Pachymetry 556 µm — 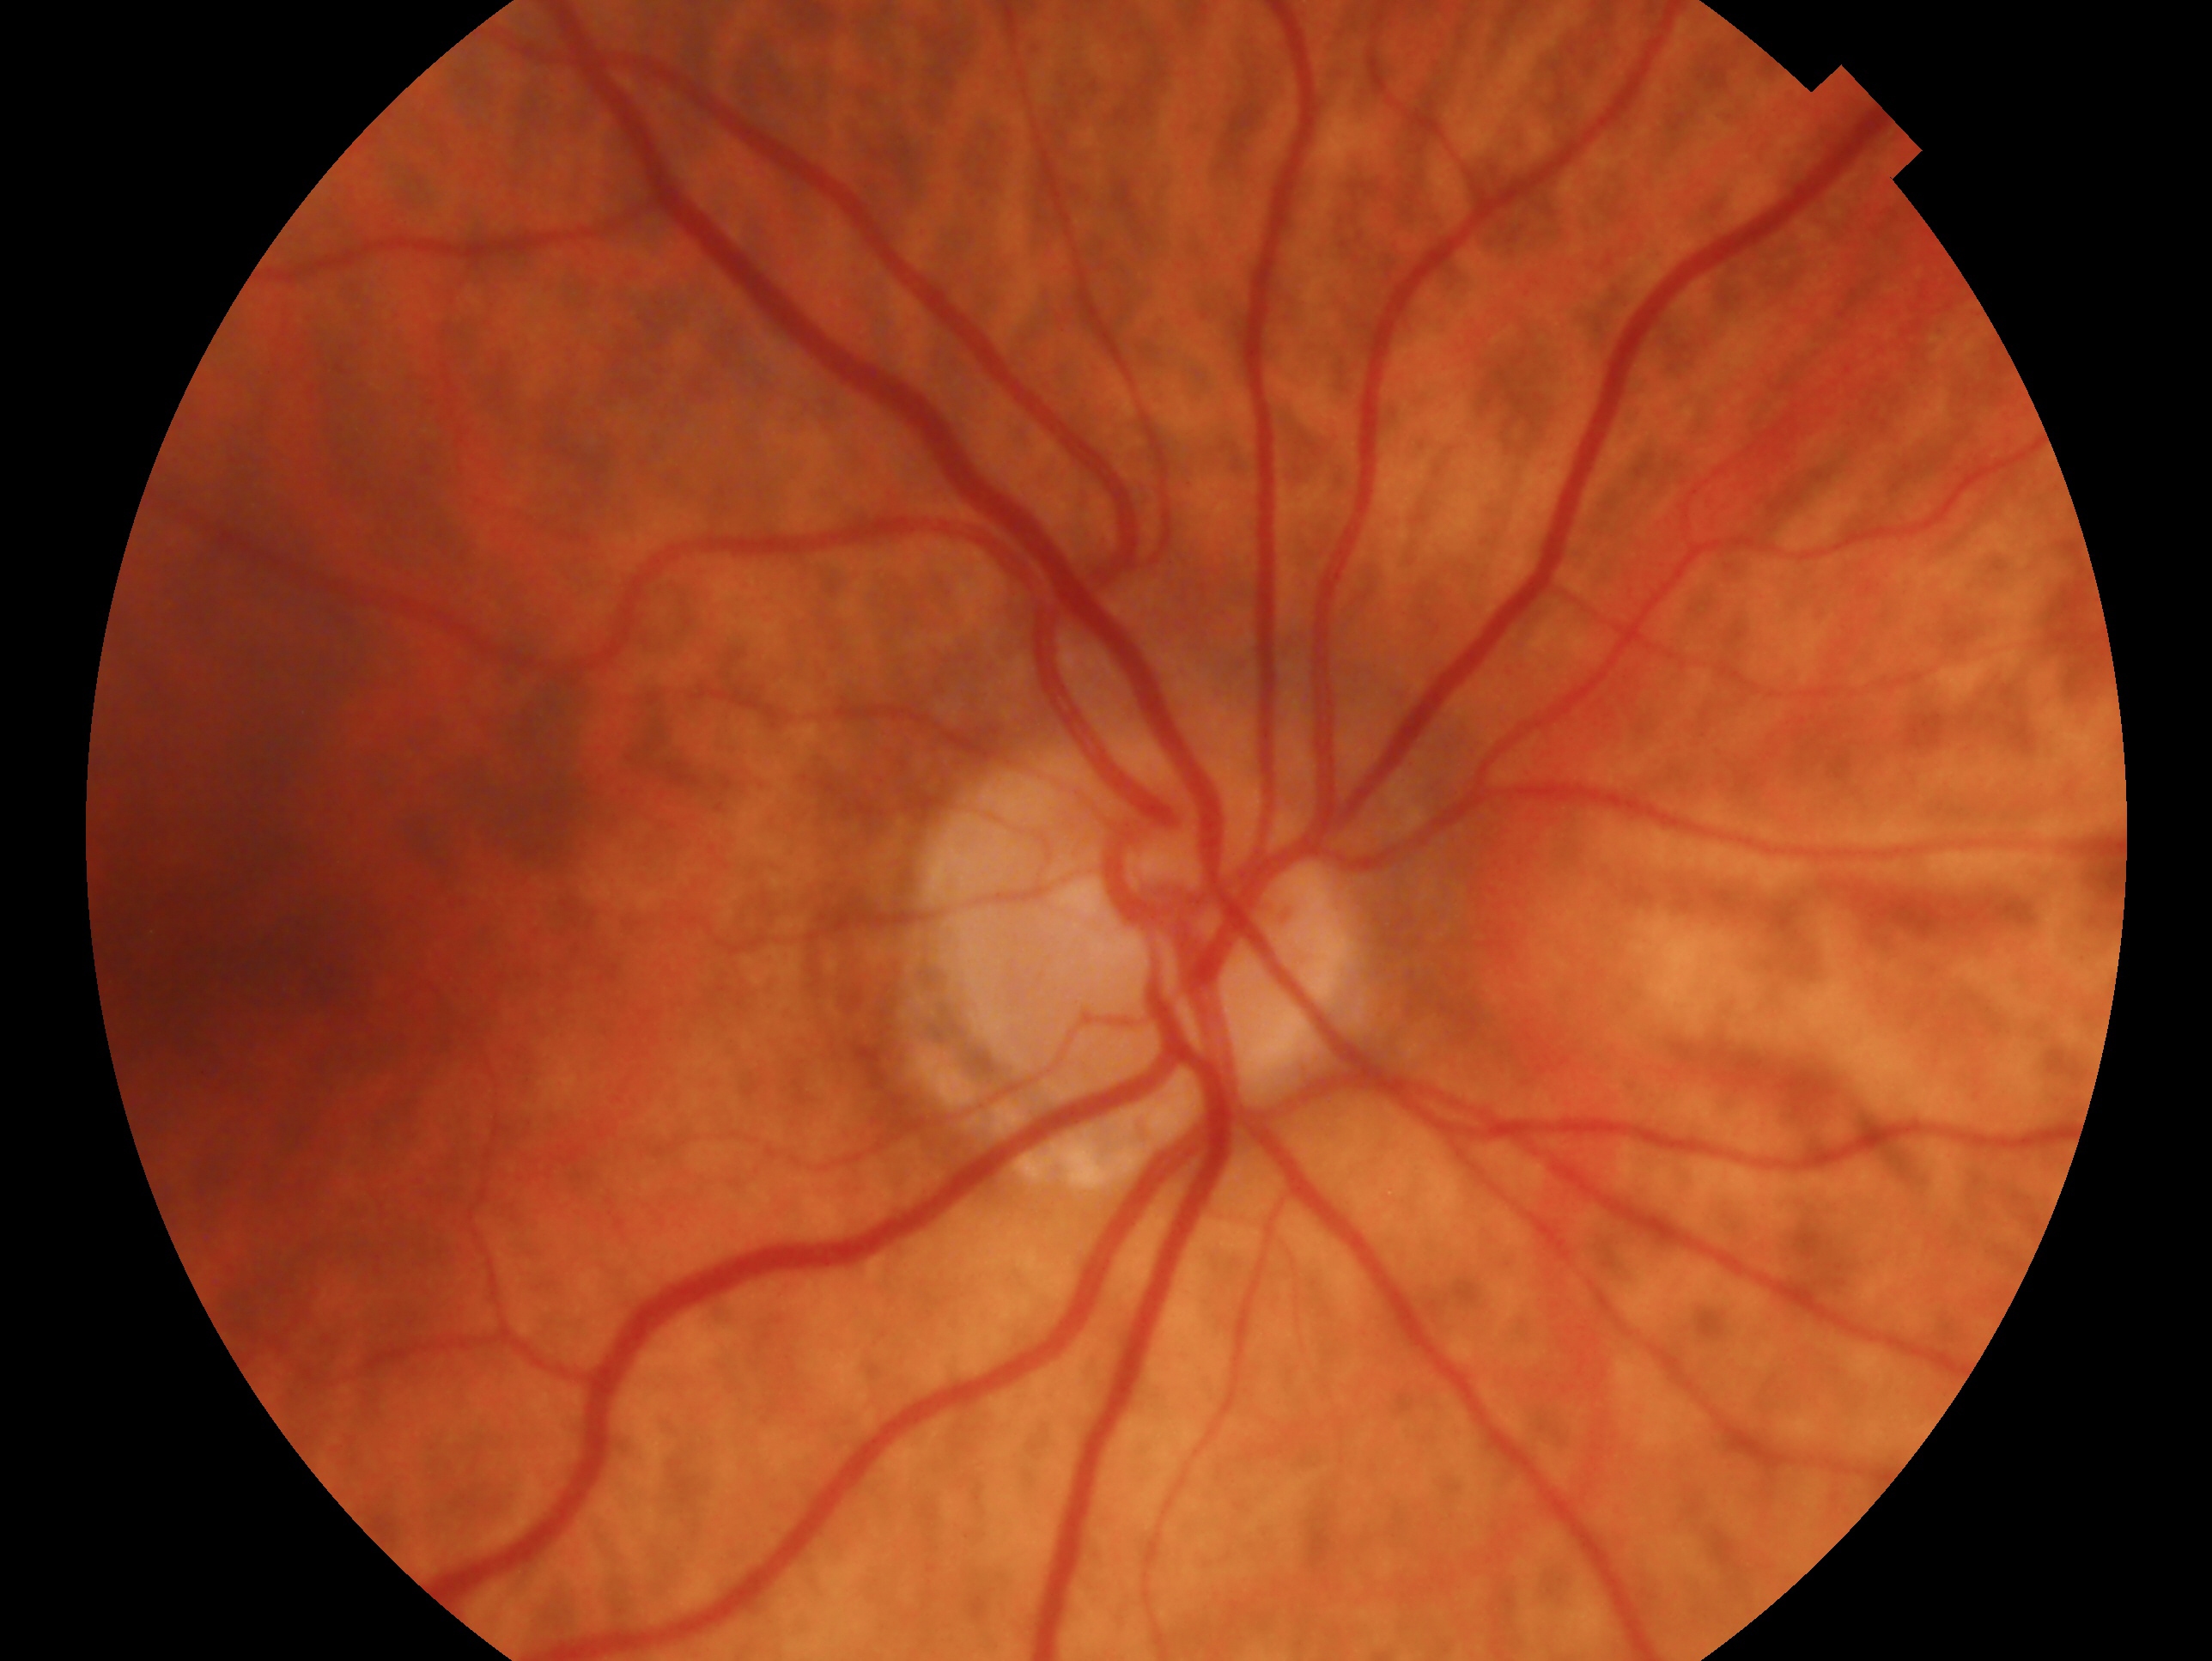
glaucoma diagnosis=no glaucoma — no clinical evidence of glaucoma in this eye; laterality=oculus dexter.